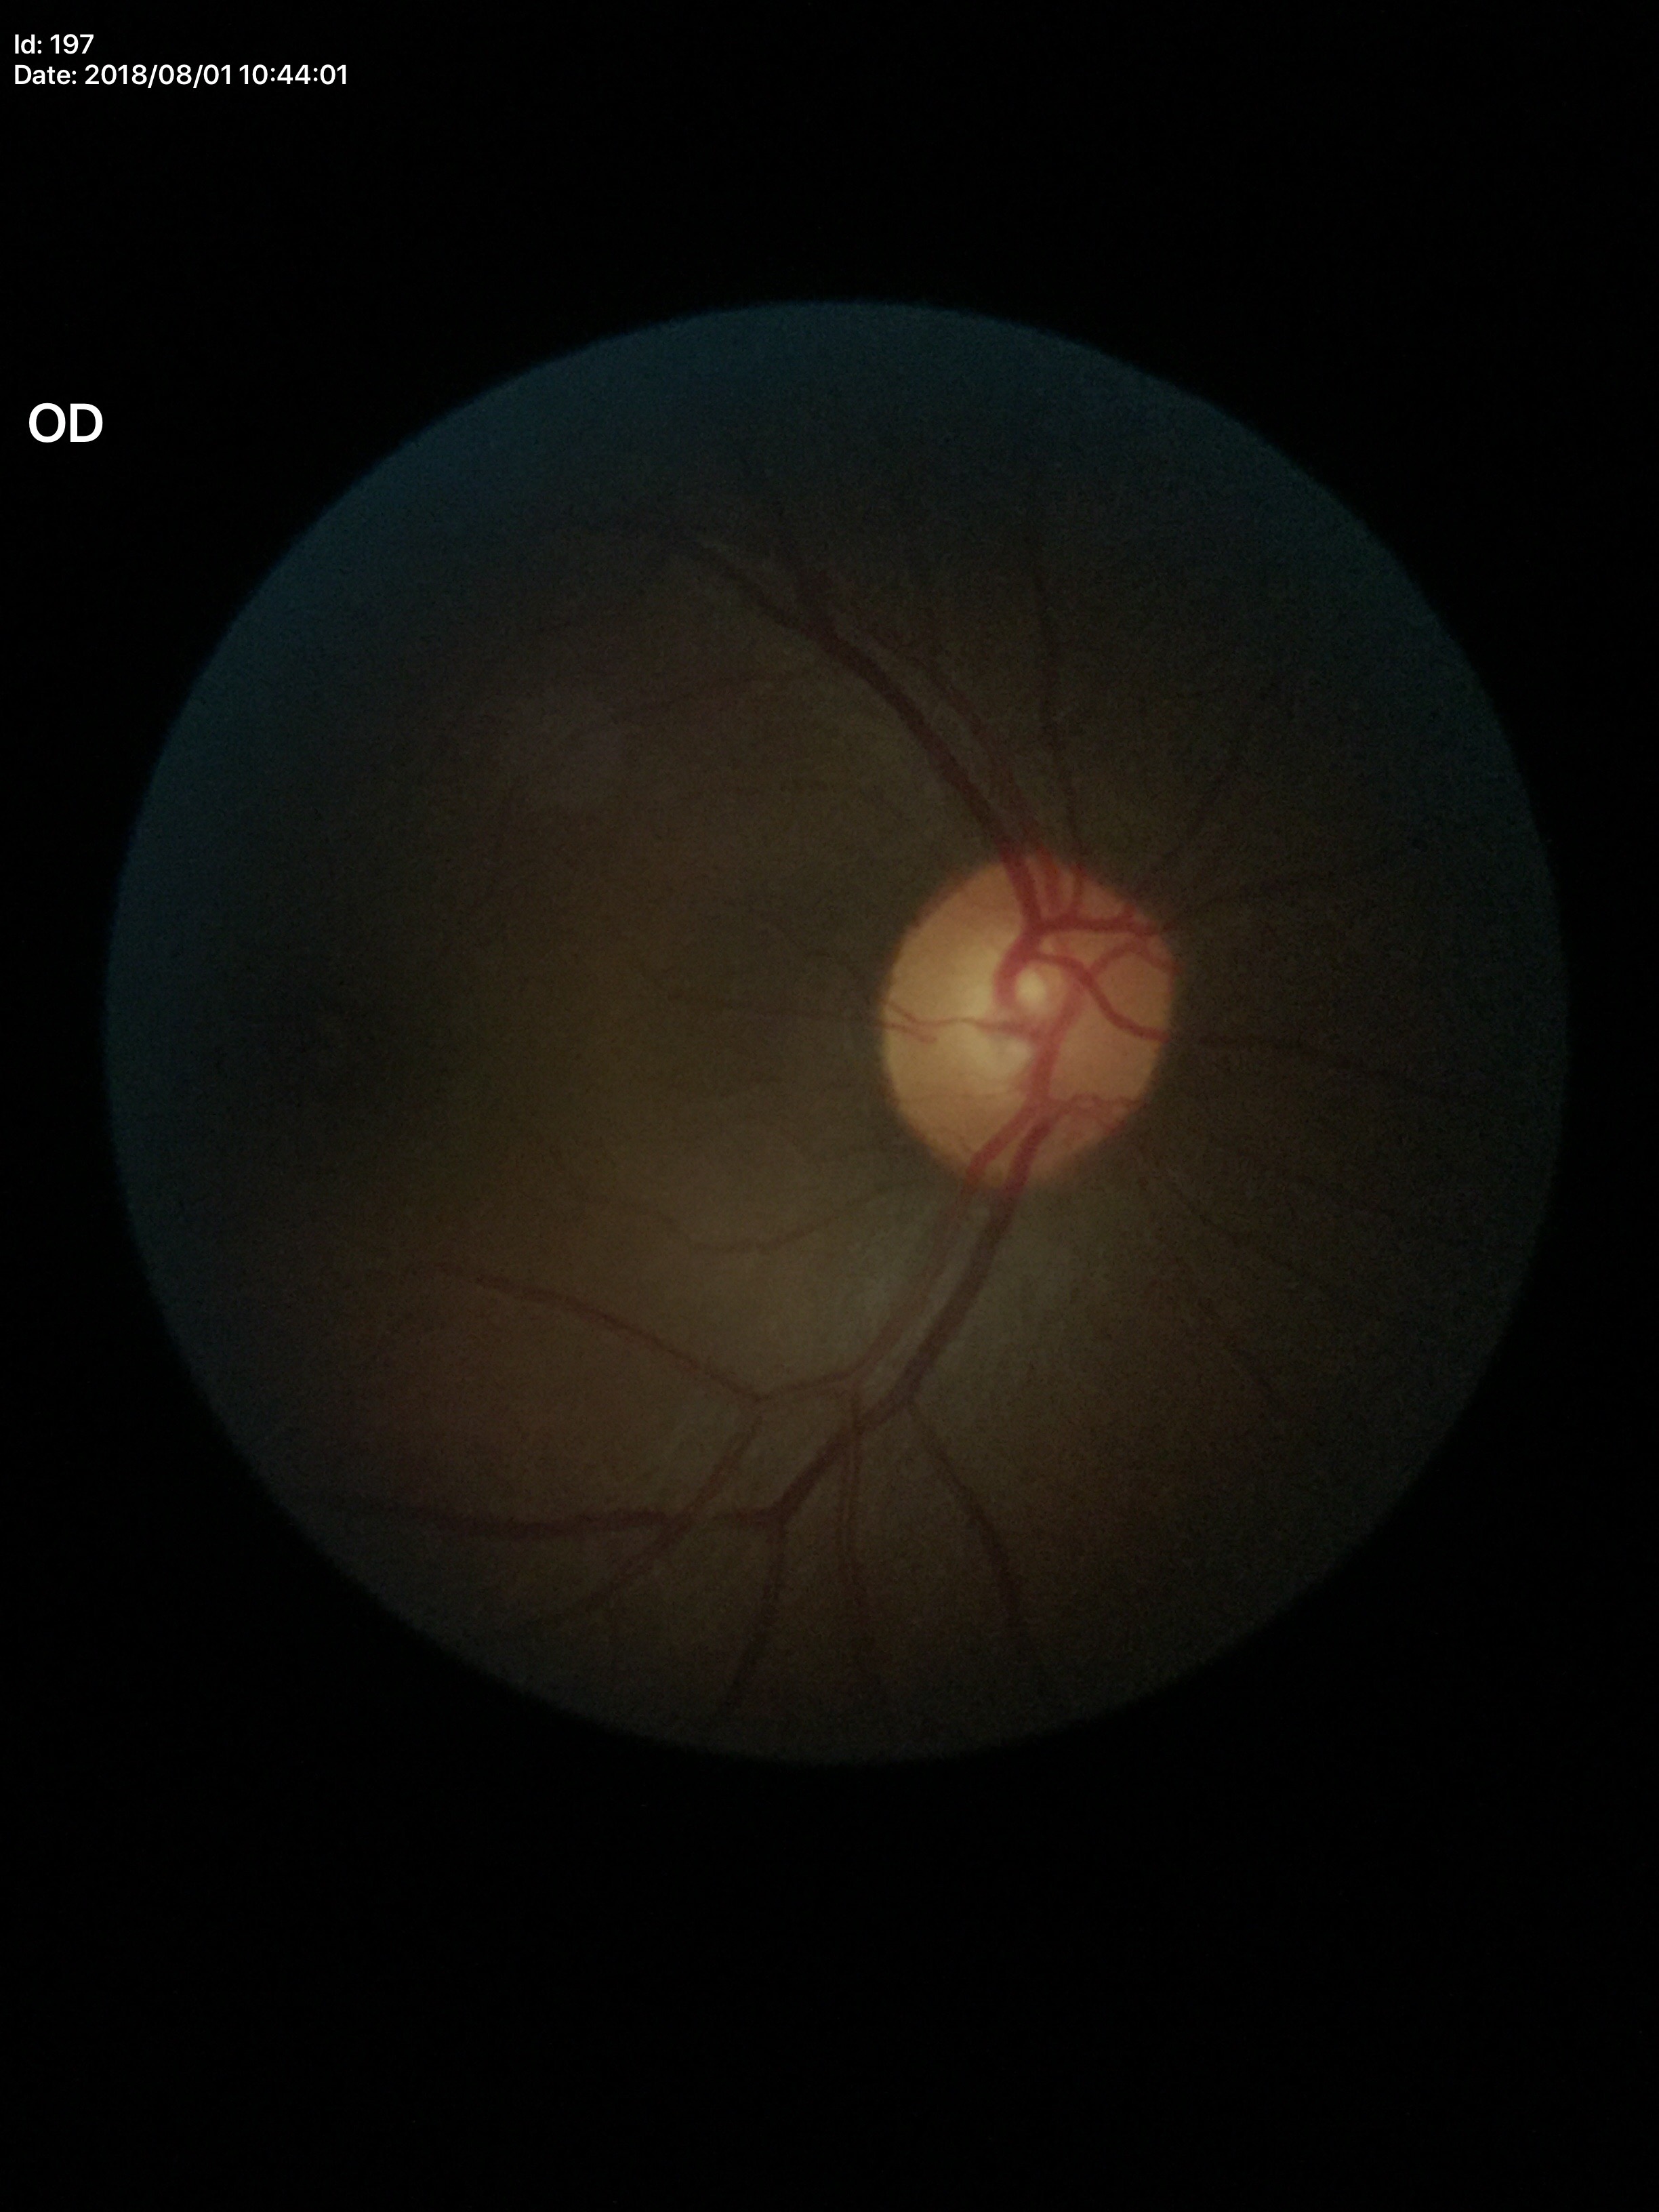
{"glaucoma_decision": "no suspicious findings (two of five ophthalmologists flagged glaucoma suspect)", "vcdr": "0.60"}